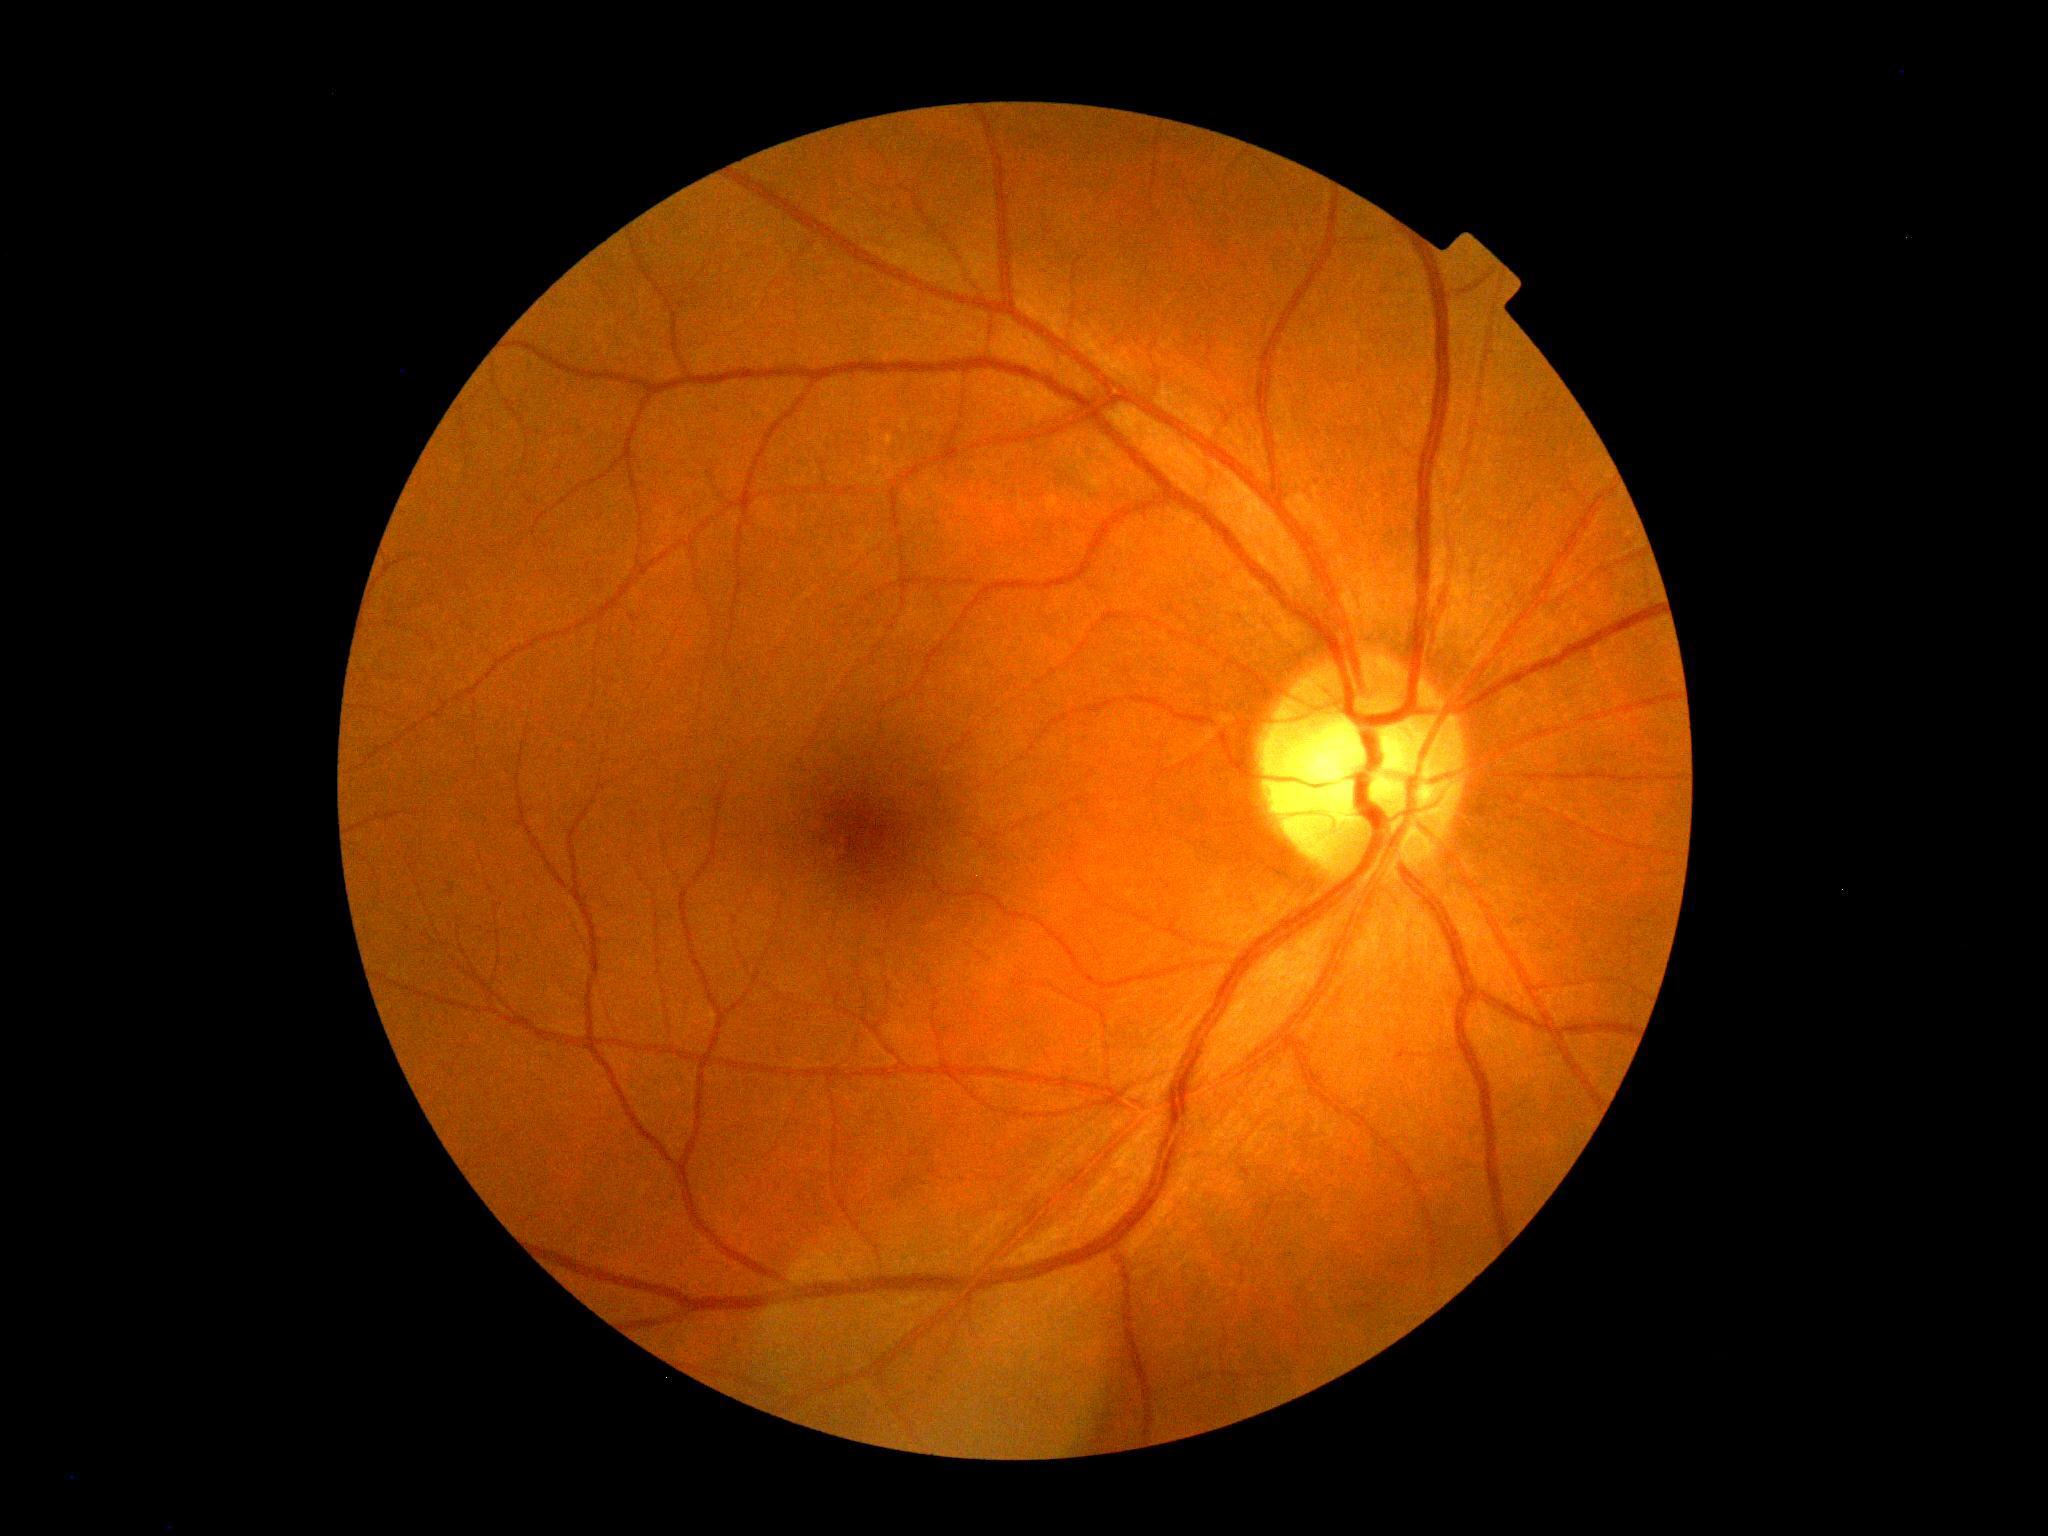 No diabetic retinal disease findings. Diabetic retinopathy is grade 0 (no apparent retinopathy) — no visible signs of diabetic retinopathy.